45 degree fundus photograph · color fundus image — 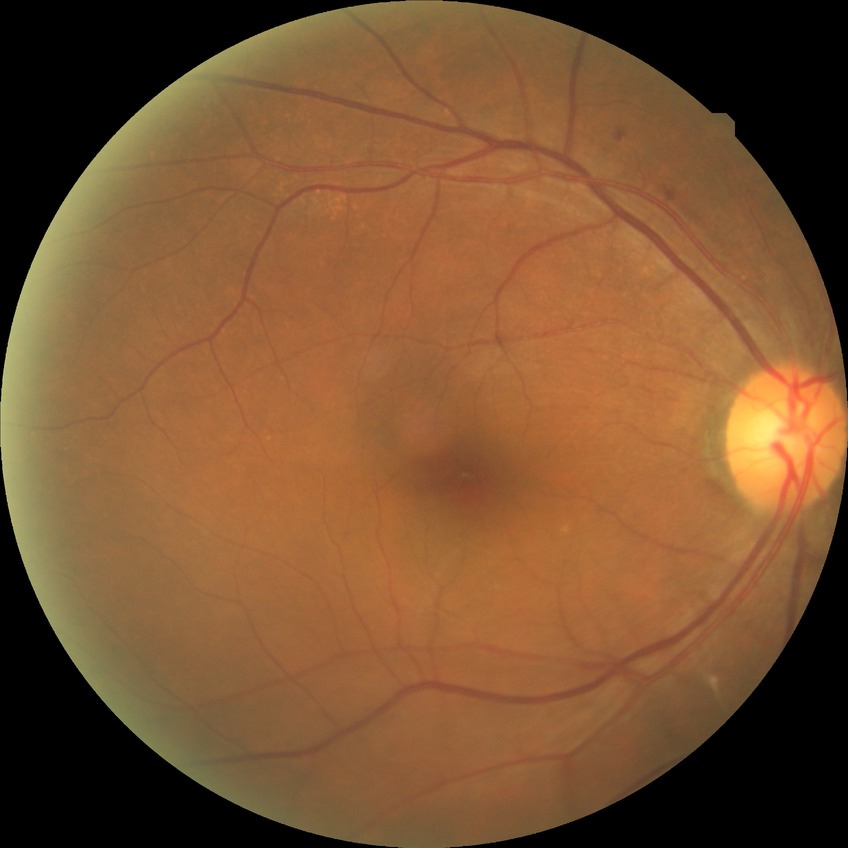 Modified Davis classification is no diabetic retinopathy.